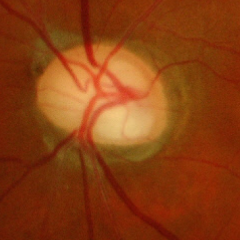

Diagnosis: advanced glaucoma.